Acquired on the Natus RetCam Envision. Infant wide-field fundus photograph. 1440x1080px
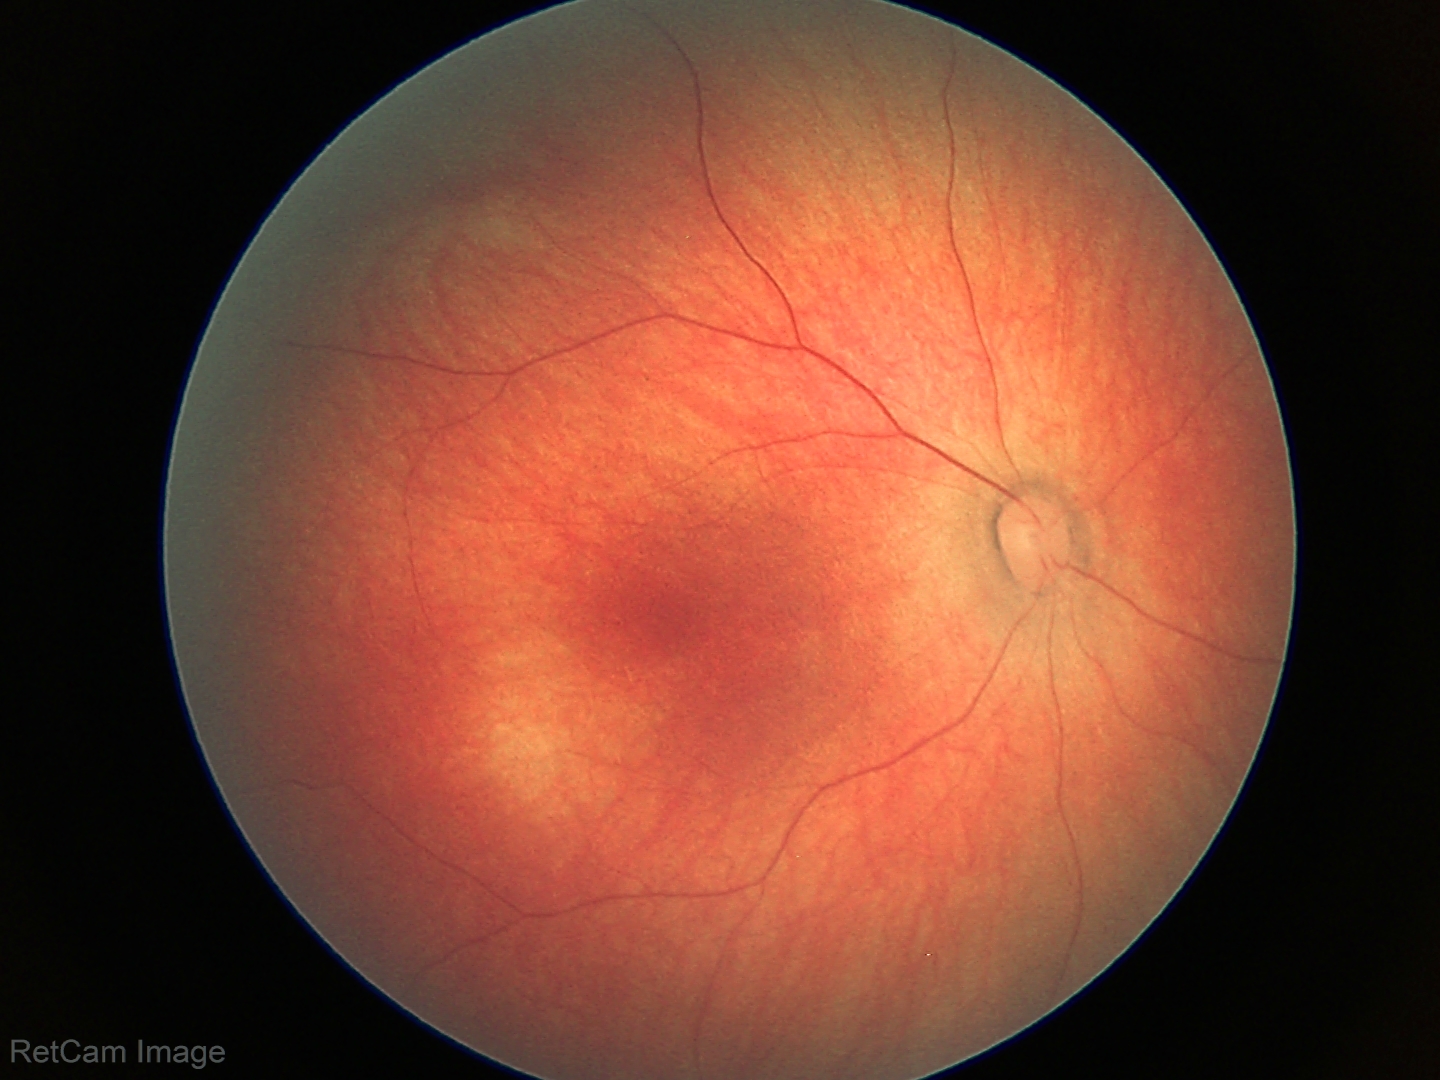 Normal screening examination.